45° FOV. CFP. 2352 by 1568 pixels.
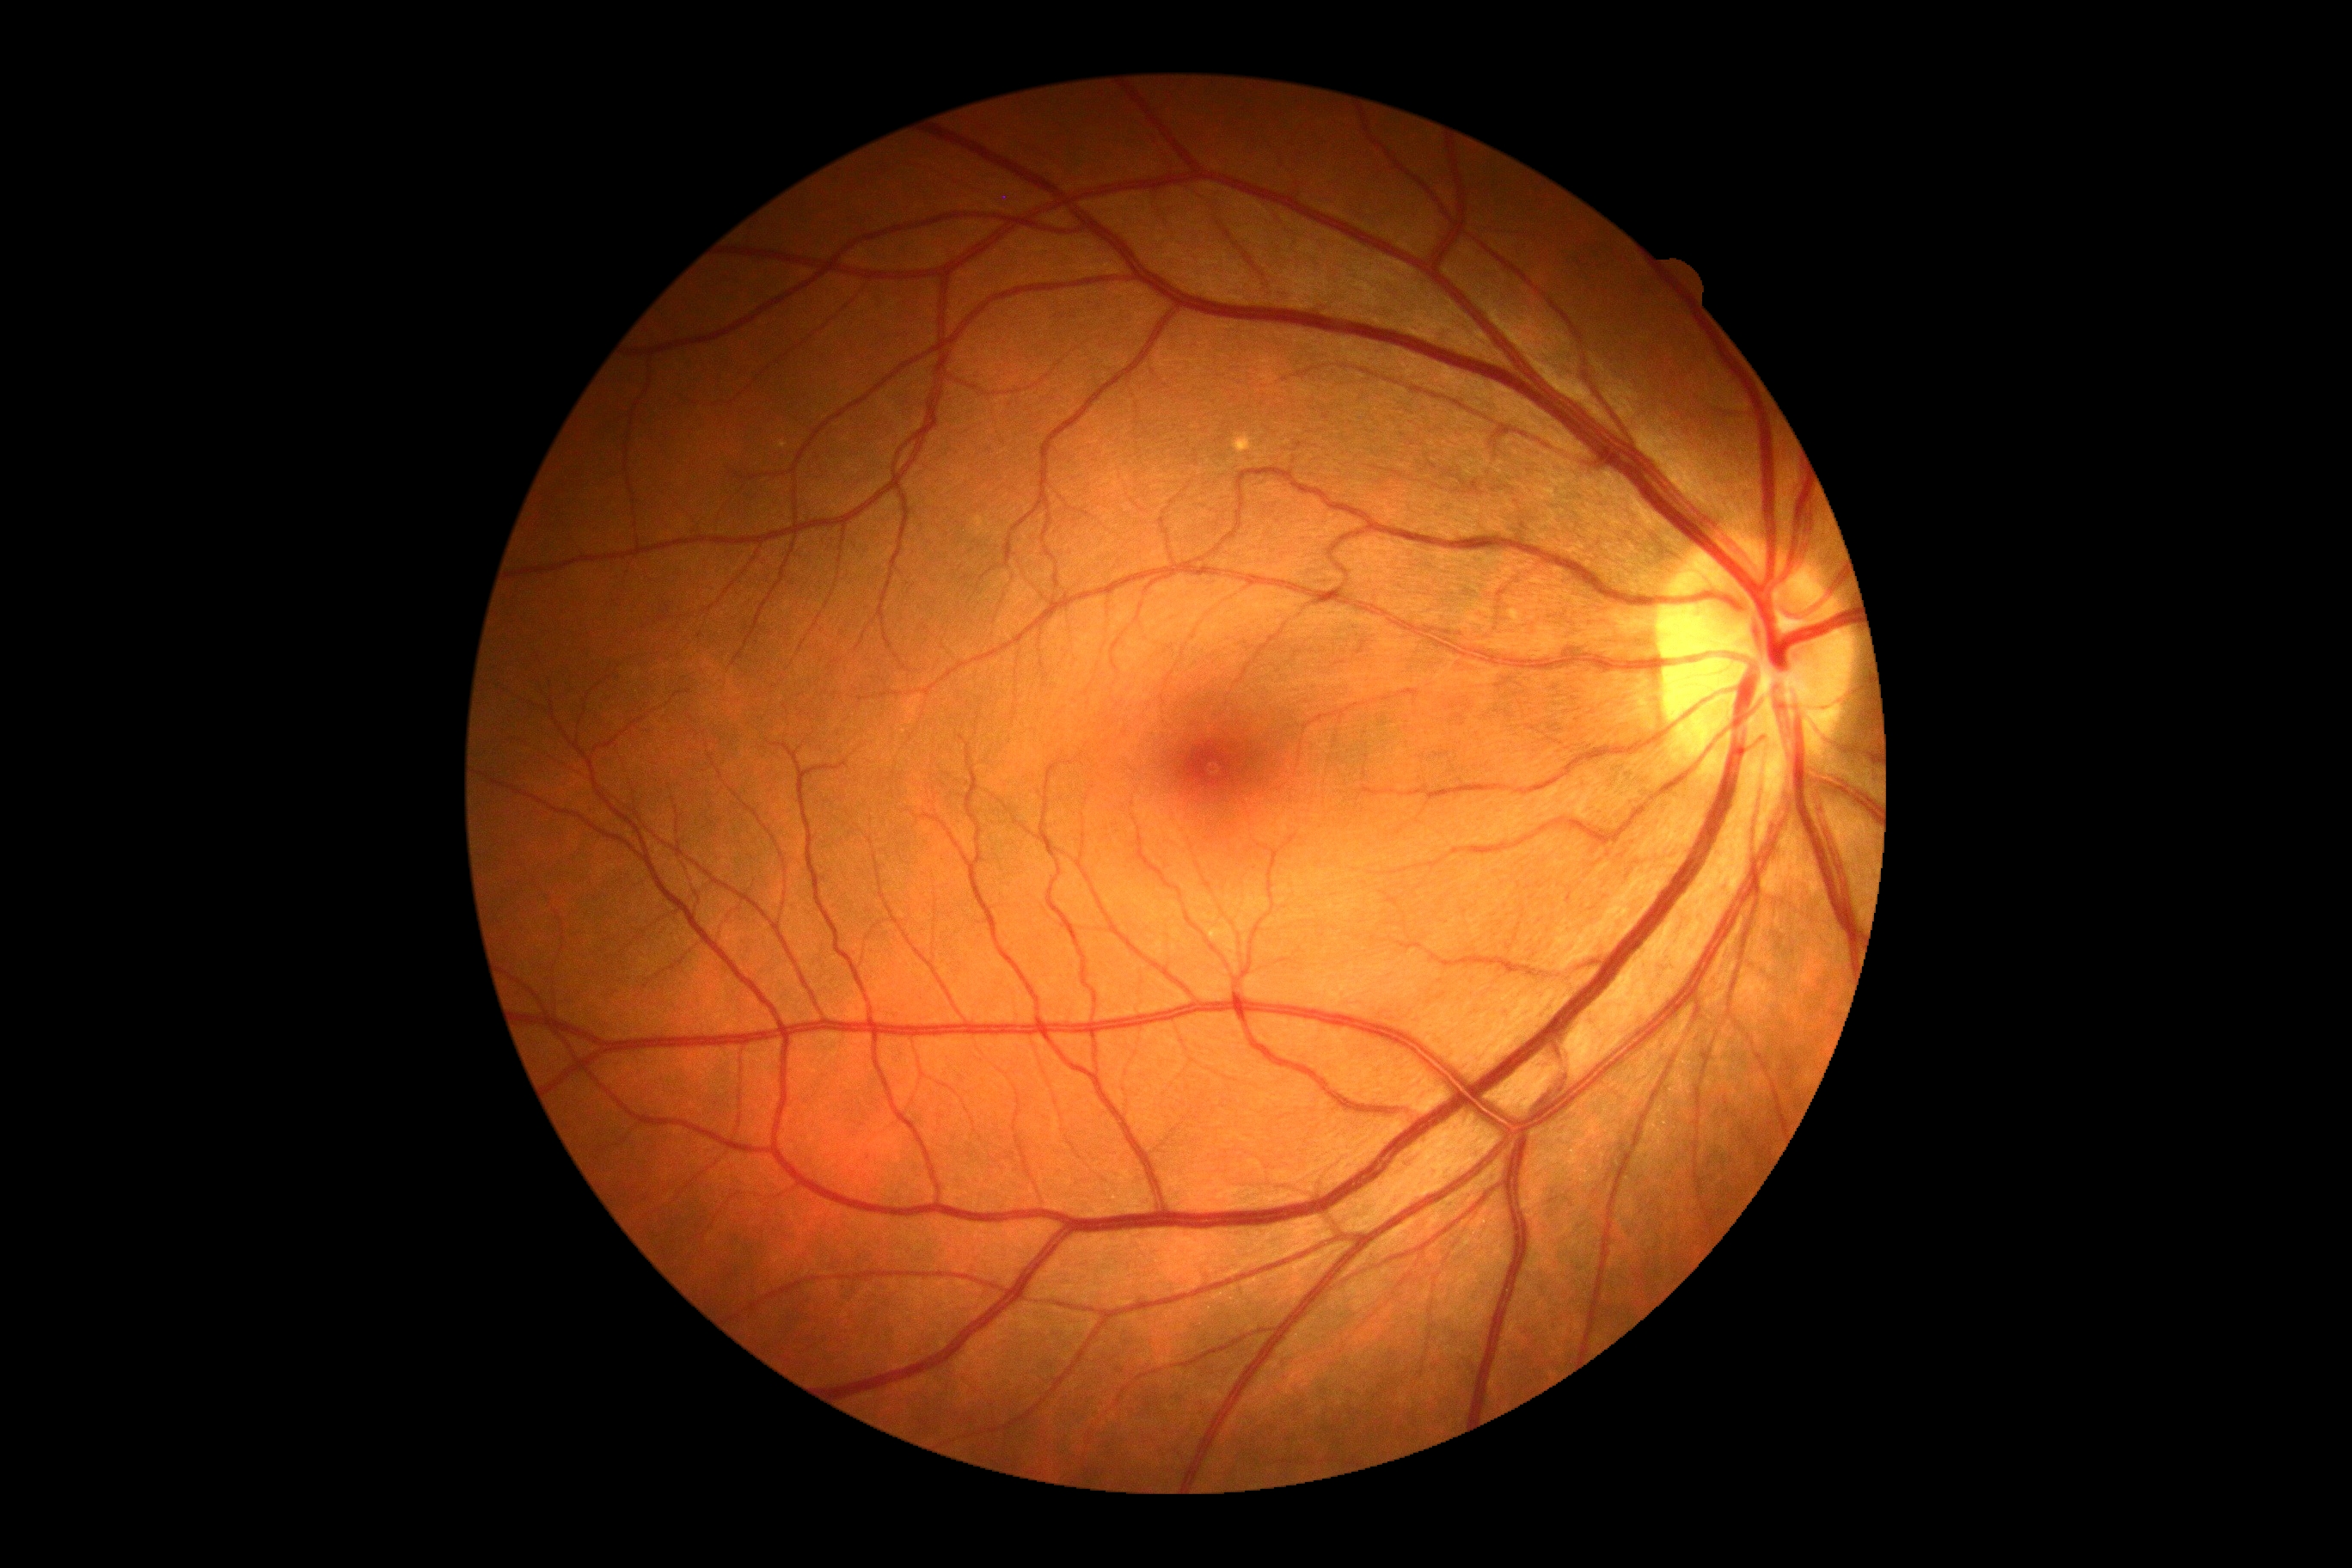 Findings:
– diabetic retinopathy grade — no apparent retinopathy (0)